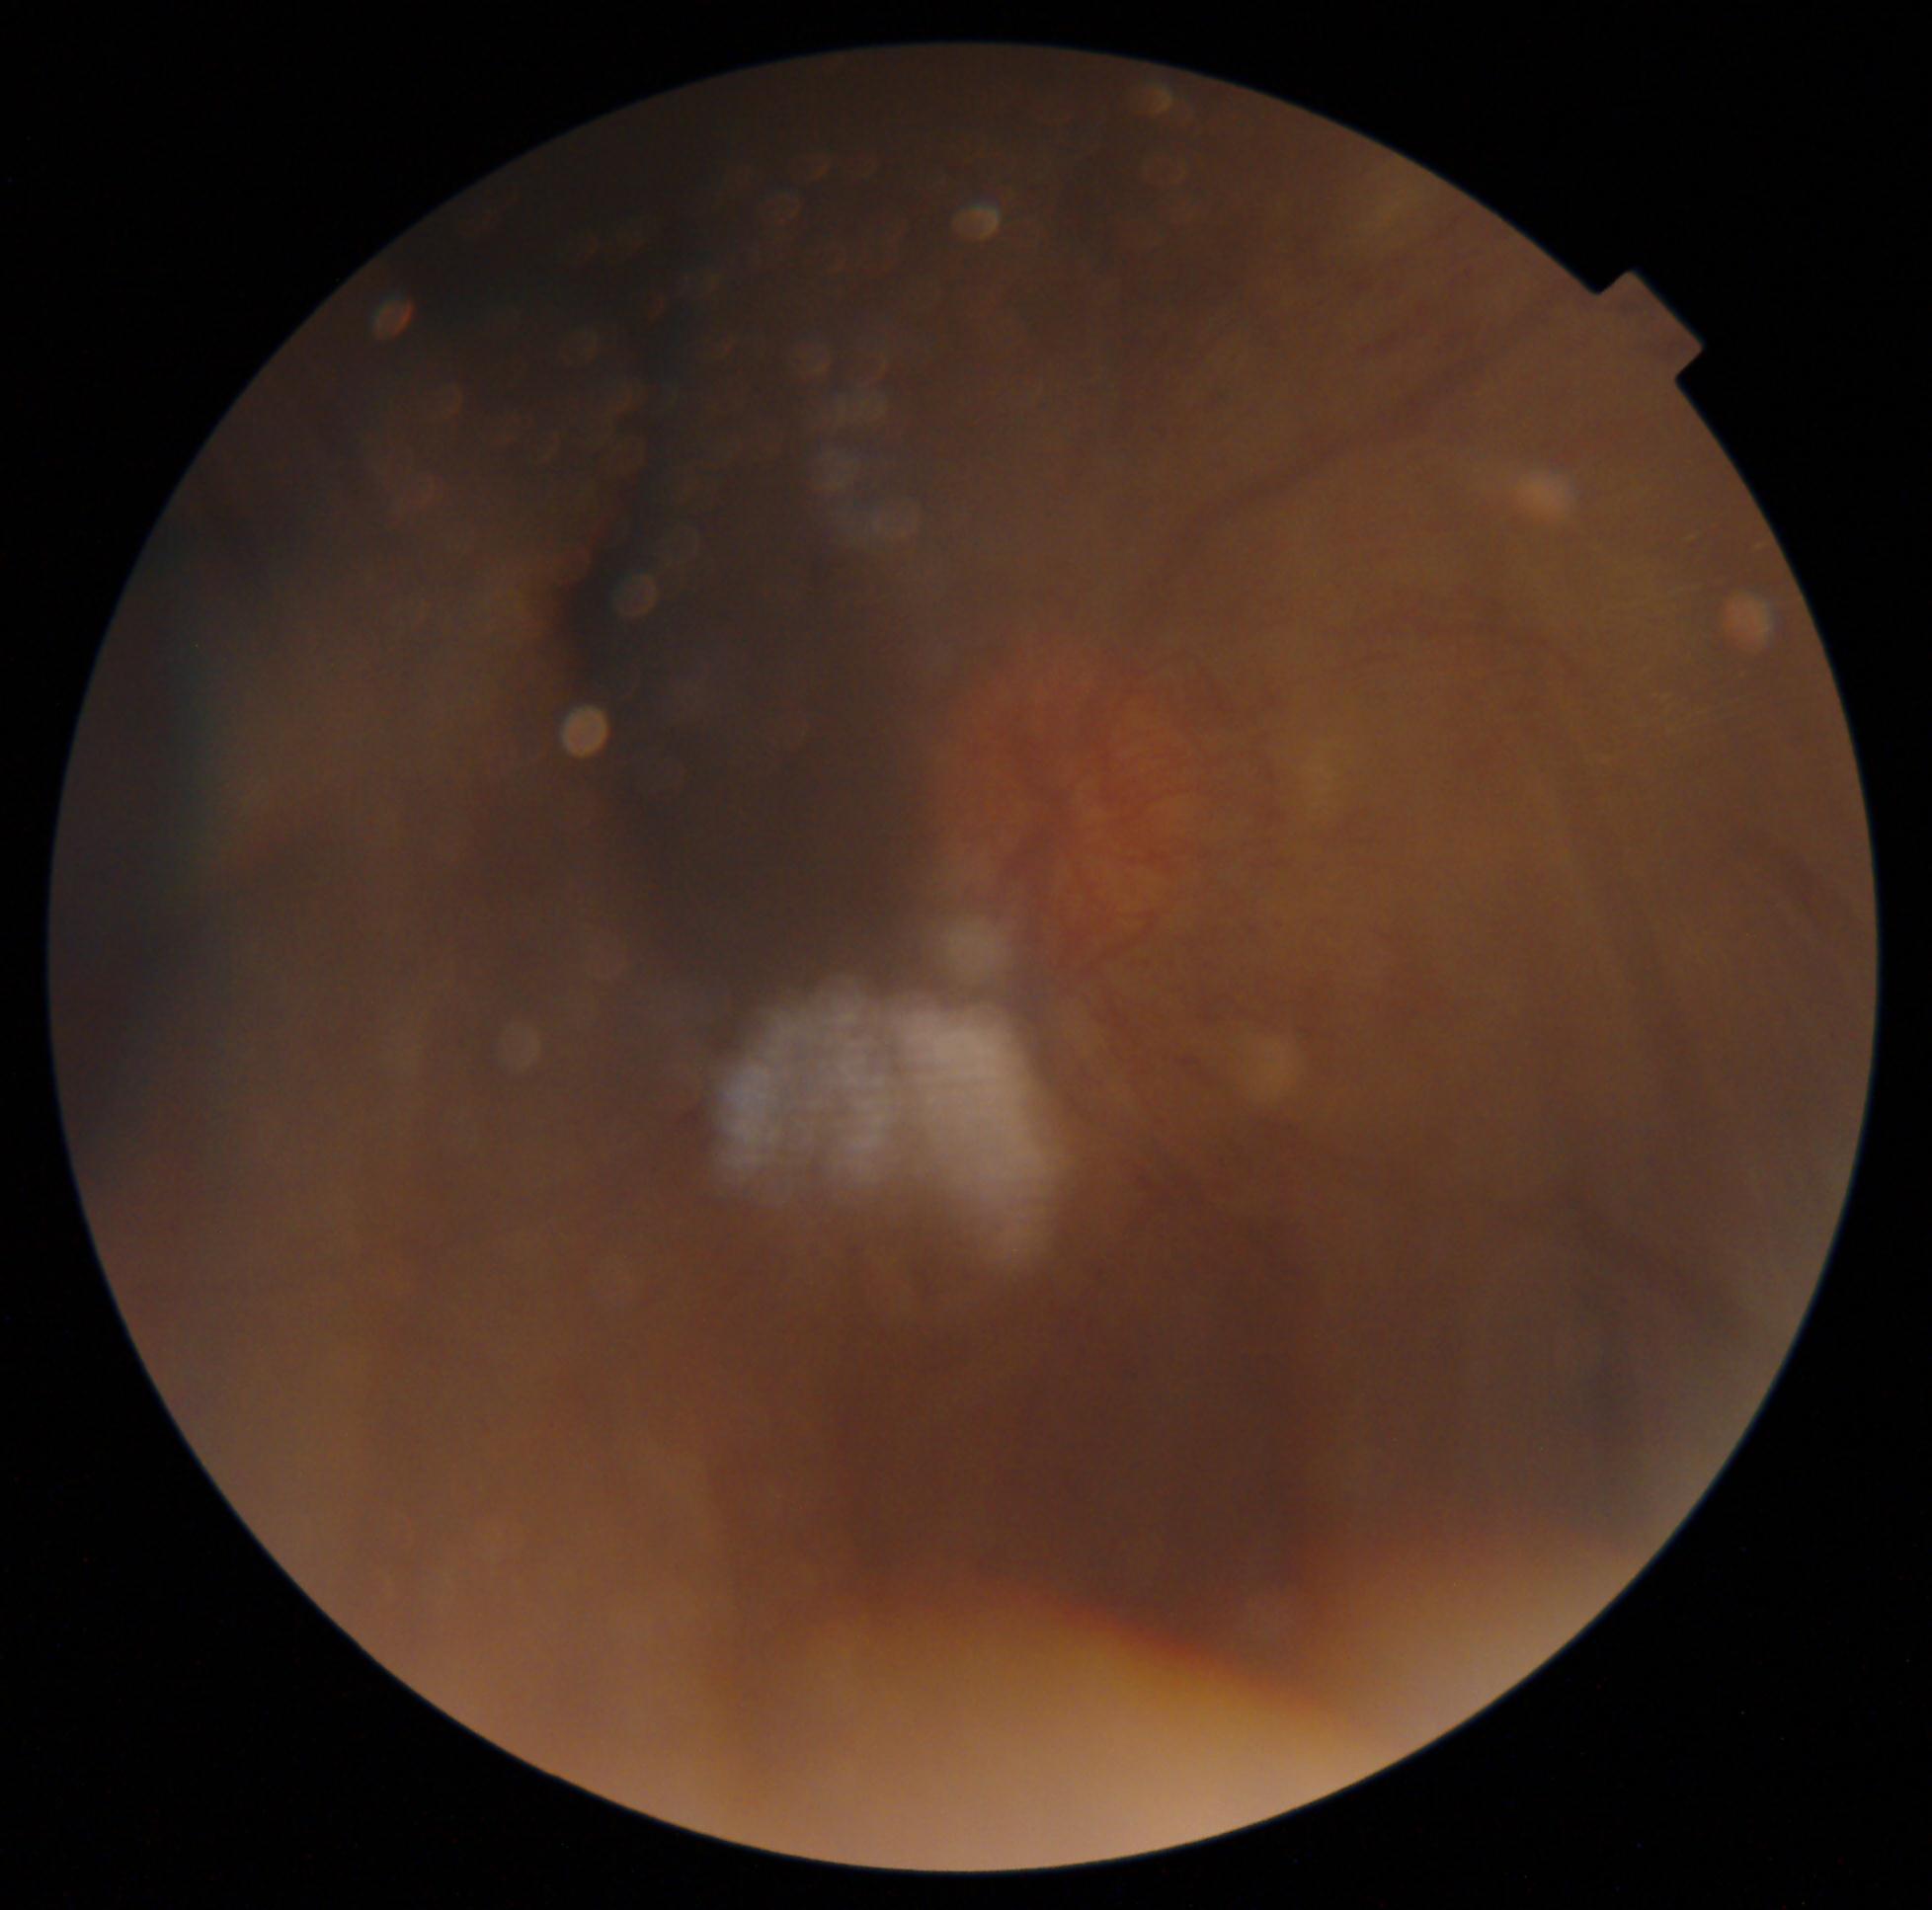
diabetic retinopathy grade: 4 (PDR).